NIDEK AFC-230. DR severity per modified Davis staging
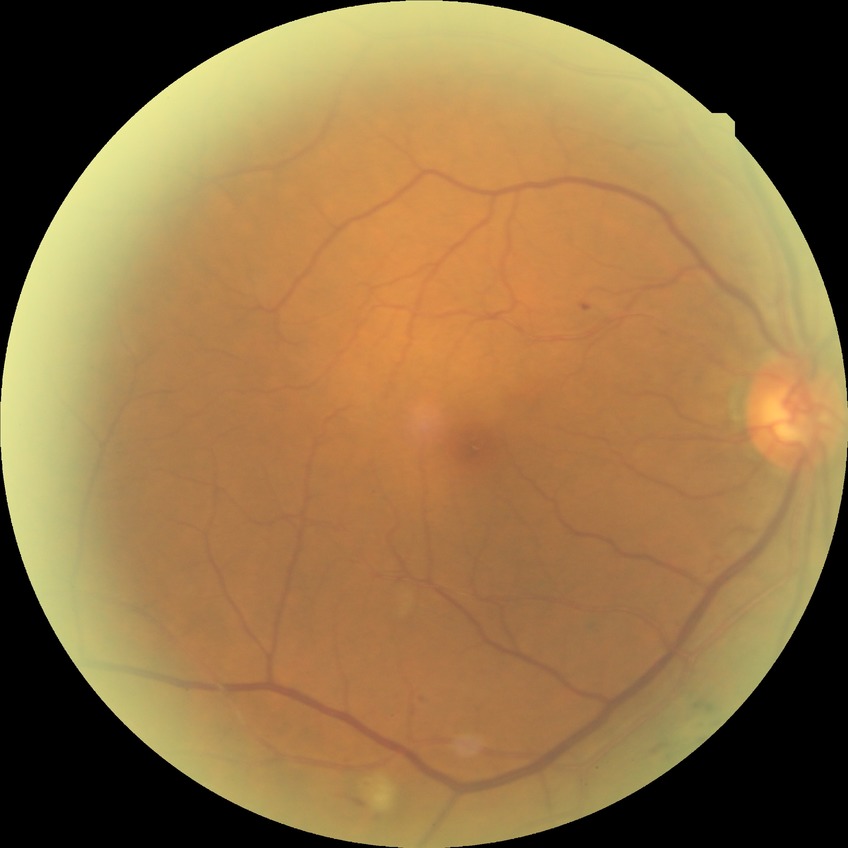

  davis_grade: simple diabetic retinopathy
  proliferative_class: non-proliferative diabetic retinopathy